1932 x 1923 pixels
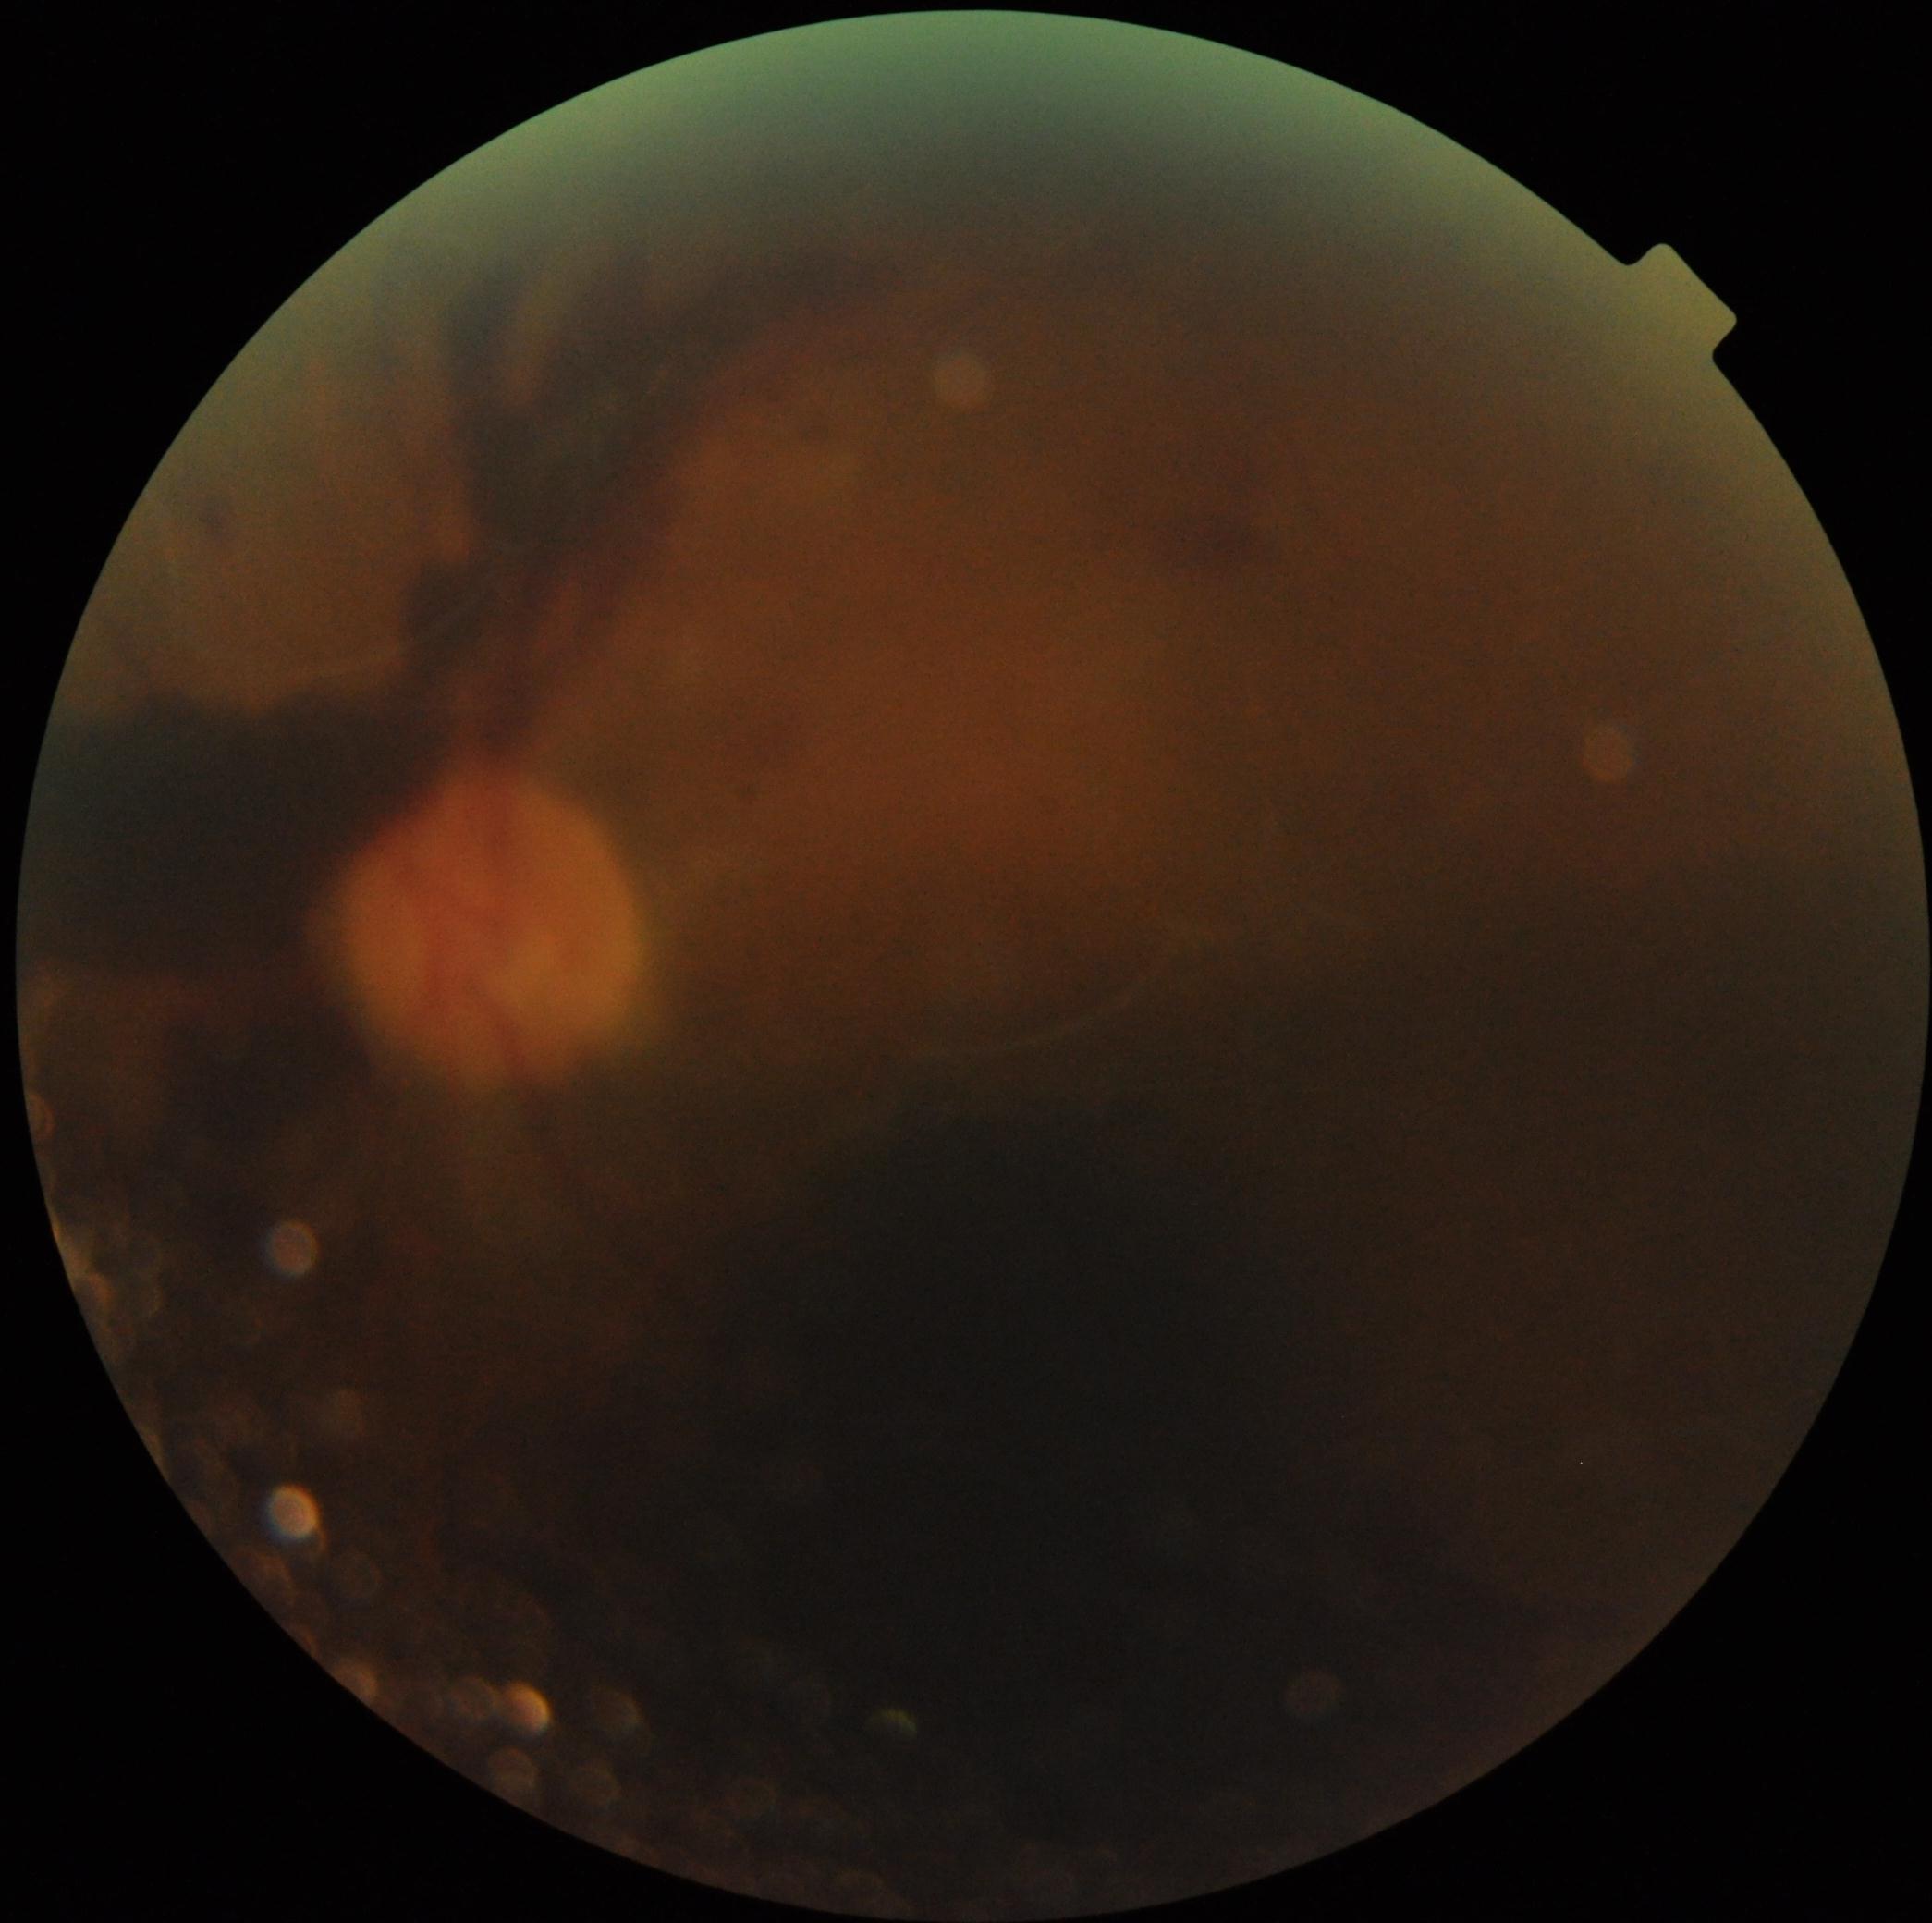

{"dr_grade": "4 (PDR)", "dr_category": "proliferative diabetic retinopathy"}